100° field of view (Phoenix ICON). Wide-field fundus photograph of an infant. 1240x1240:
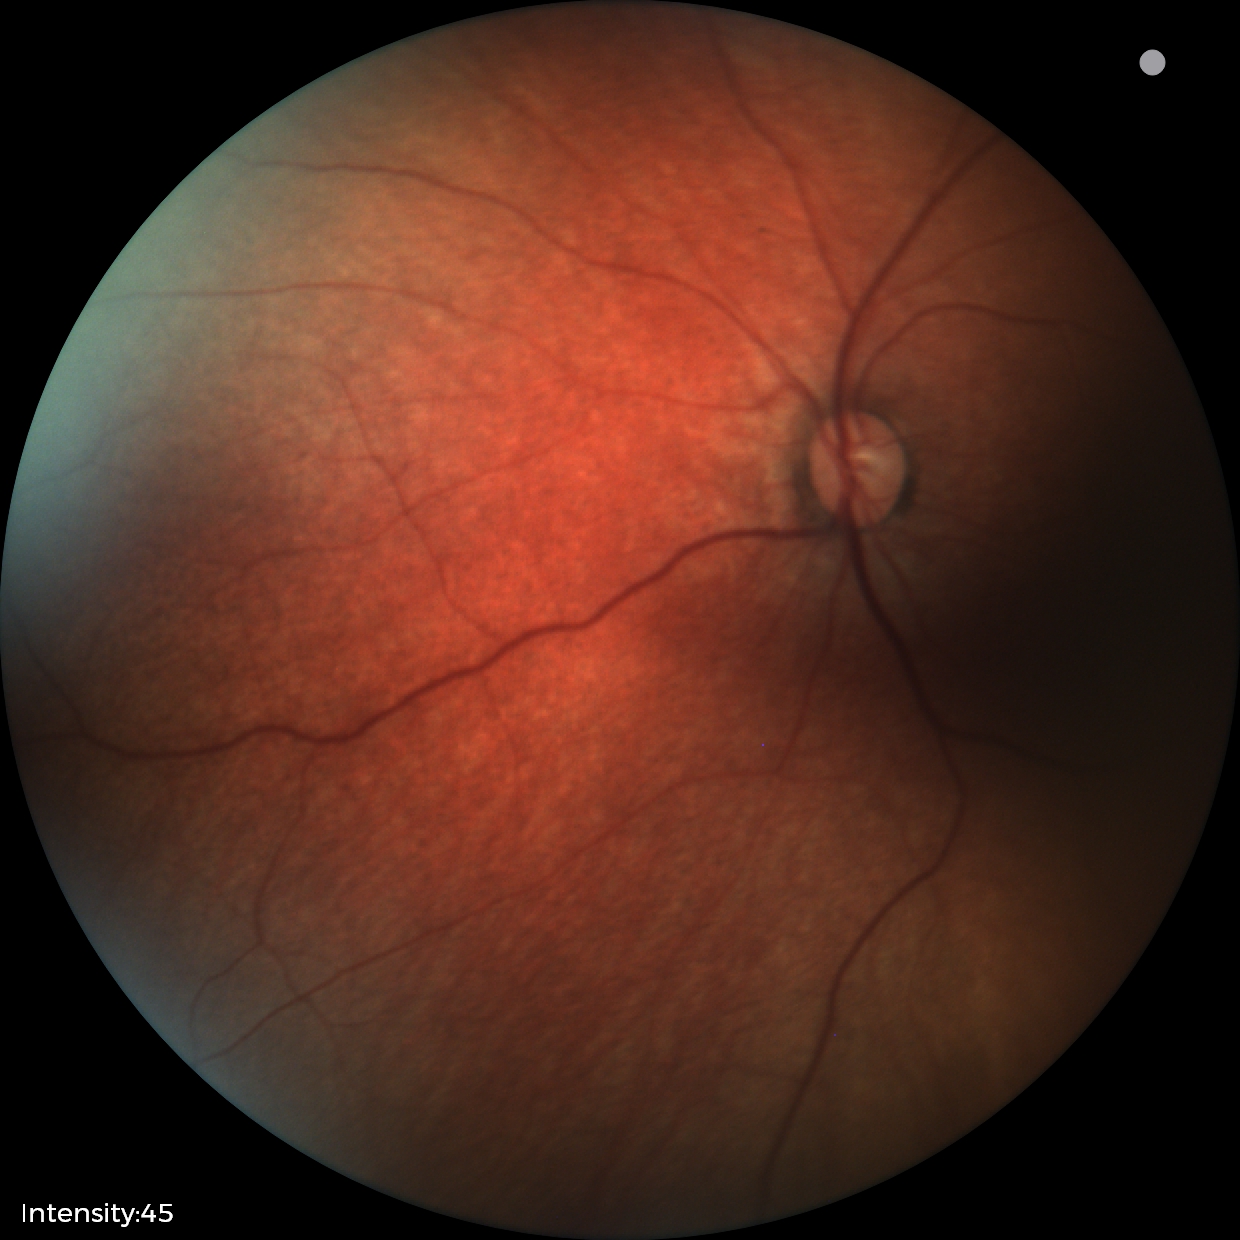

Screening: physiological finding.